Retinal fundus photograph: 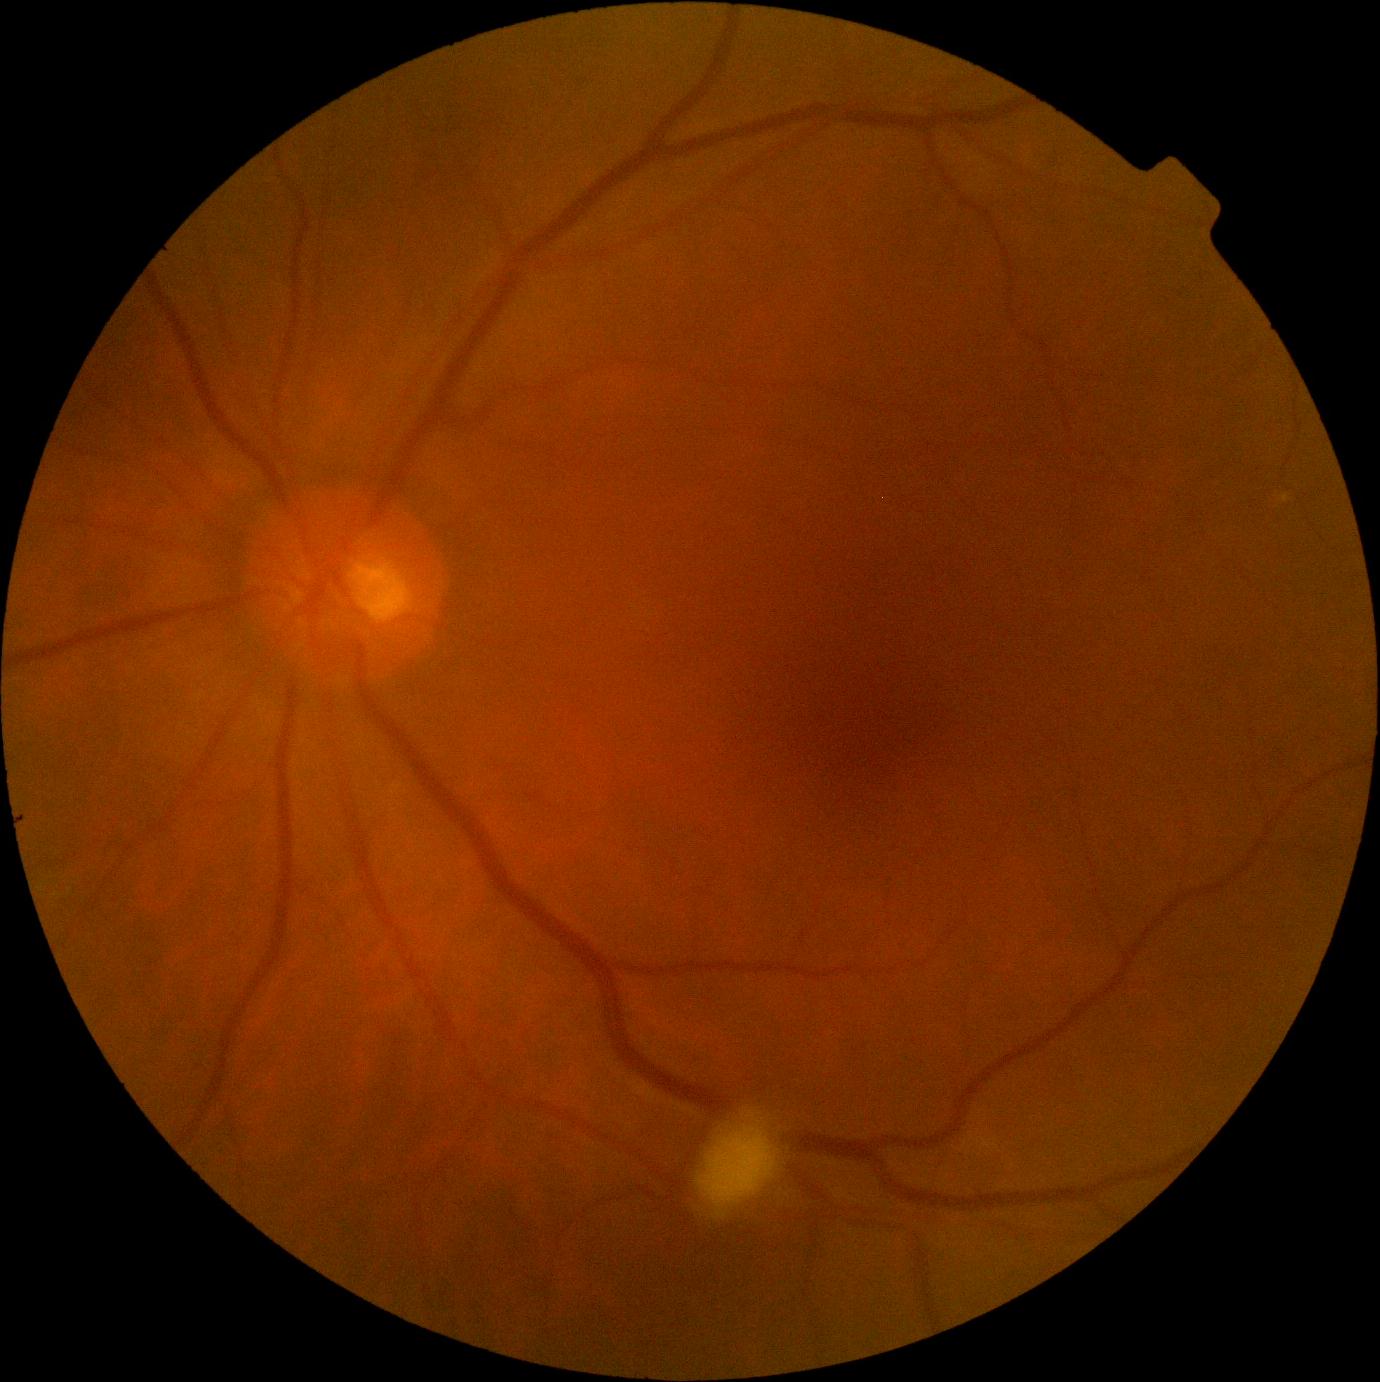
Diabetic retinopathy severity is grade 2 (moderate NPDR).
Disease class: non-proliferative diabetic retinopathy.